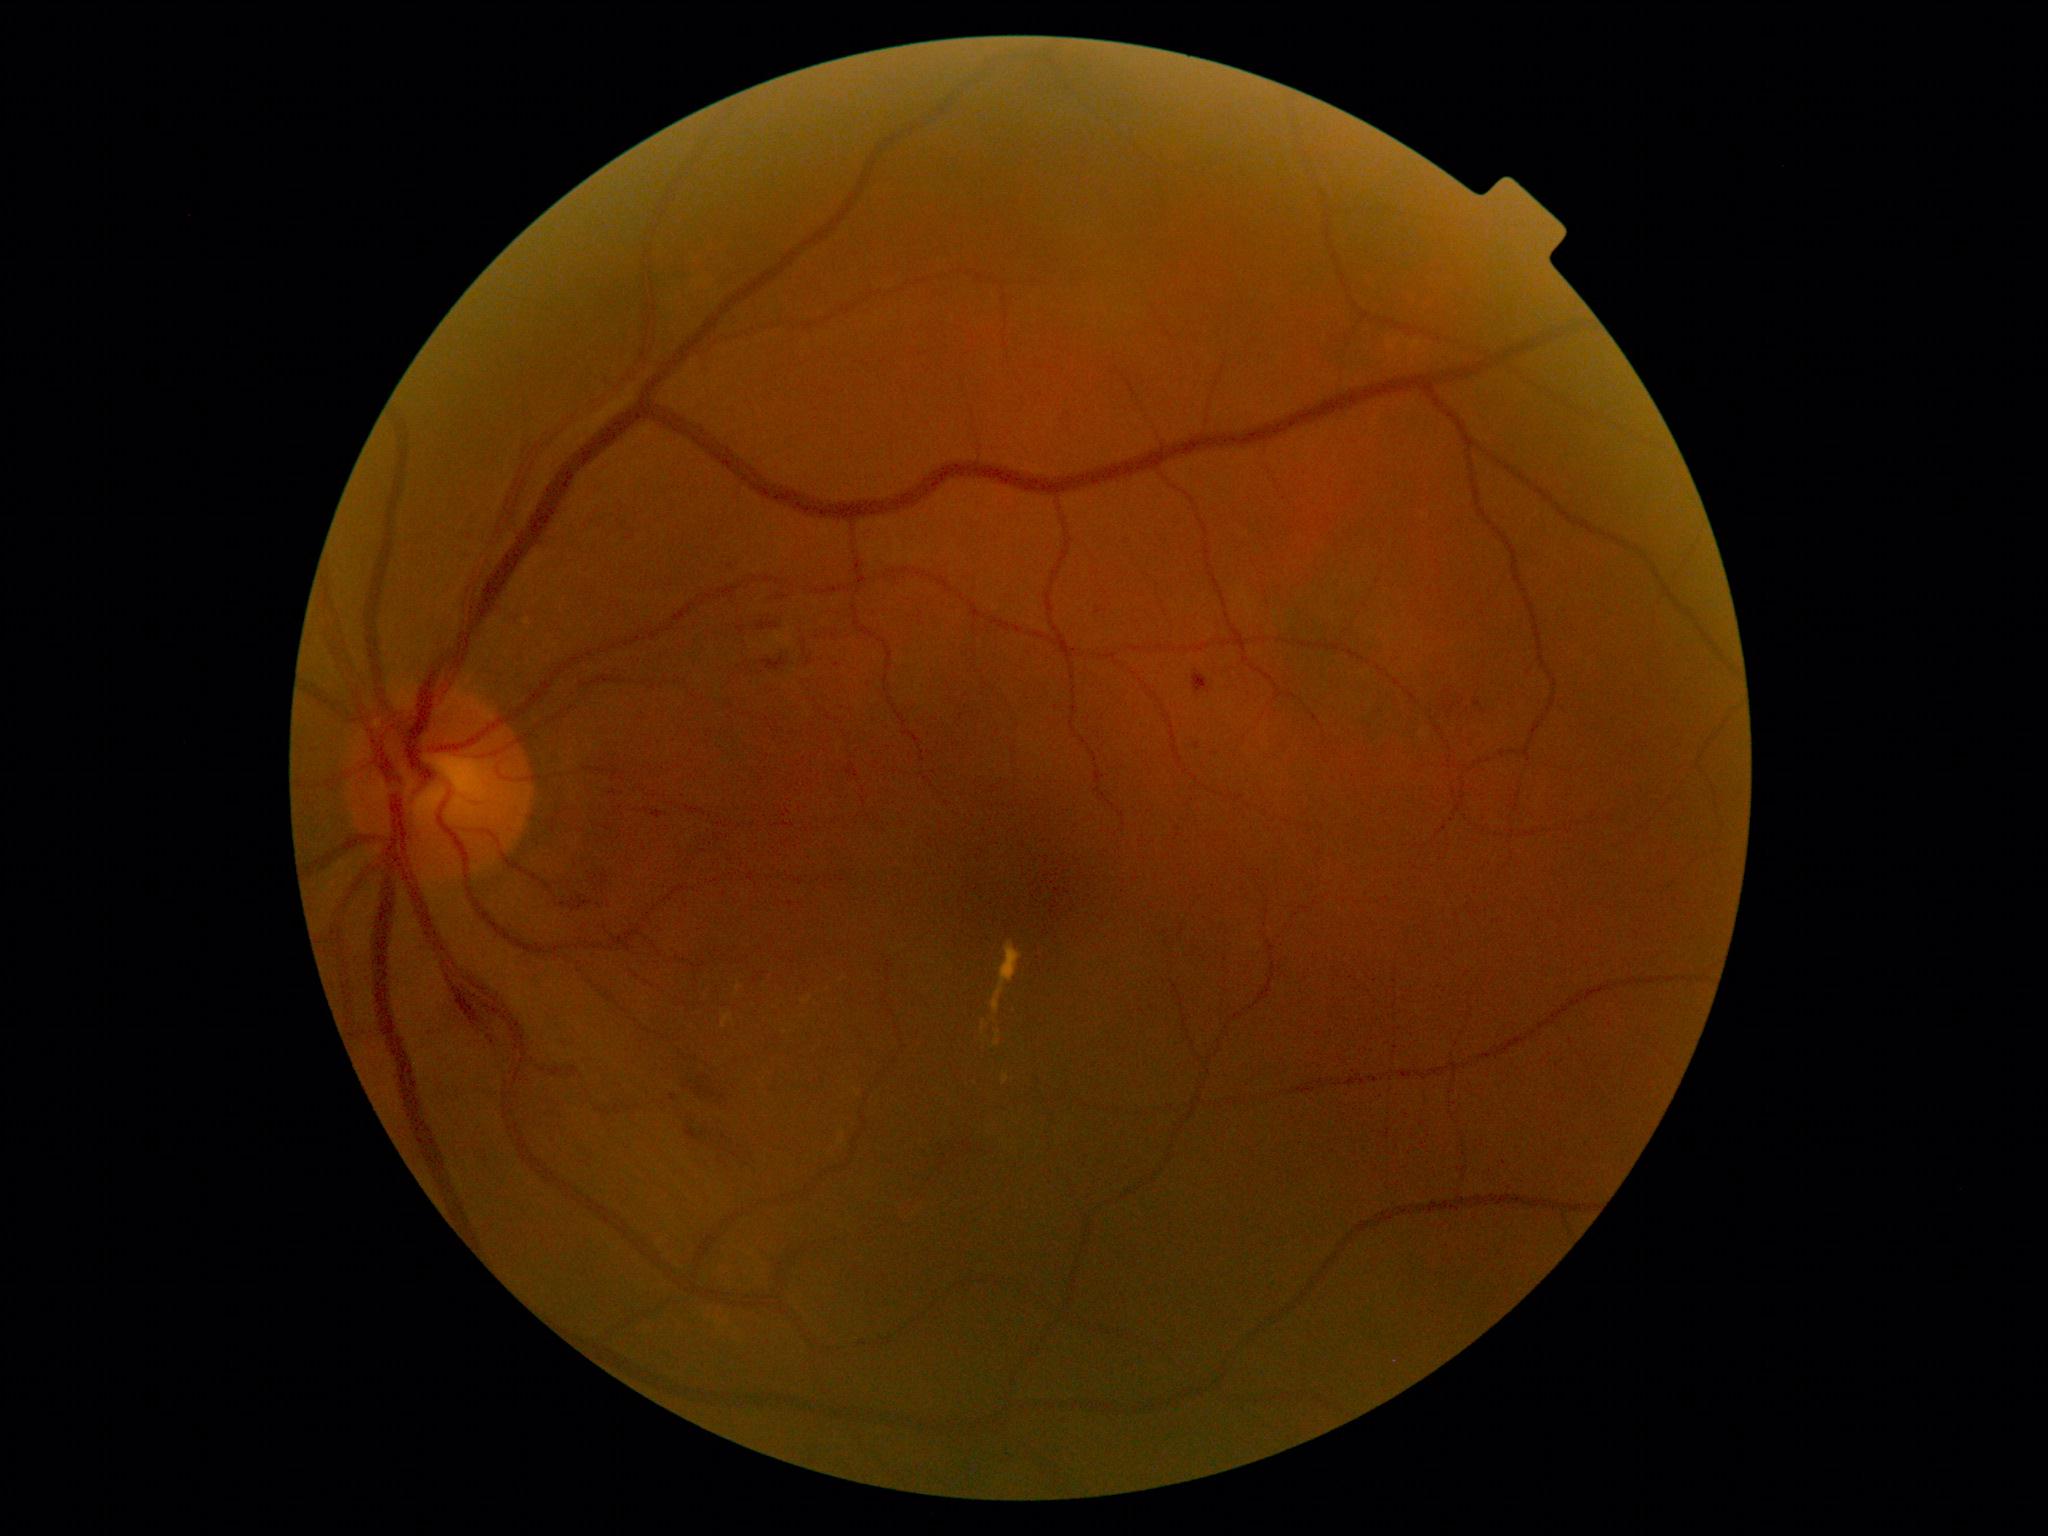

Diabetic retinopathy severity: moderate non-proliferative diabetic retinopathy (grade 2)
A subset of detected lesions:
* soft exudates: none
* hard exudates (subset): <region>981, 1022, 986, 1032</region>; <region>737, 984, 743, 992</region>; <region>722, 1013, 733, 1029</region>; <region>994, 1032, 1001, 1046</region>; <region>803, 997, 813, 1003</region>; <region>1003, 1073, 1010, 1085</region>; <region>991, 941, 1023, 1014</region>
* Hard exudates (small, approximate centers) near (785; 1033)
* hemorrhages (subset): <region>1474, 700, 1482, 707</region>; <region>763, 658, 788, 671</region>; <region>757, 620, 780, 631</region>; <region>452, 986, 482, 1026</region>; <region>652, 810, 664, 819</region>; <region>677, 1050, 731, 1112</region>; <region>569, 896, 594, 912</region>; <region>807, 658, 814, 666</region>; <region>682, 1113, 753, 1165</region>; <region>1193, 670, 1210, 696</region>
* Hemorrhages (small, approximate centers) near (1484; 712); (614; 793); (1198; 746); (564; 905); (837; 666); (647; 810)
* microaneurysms: none